Retinal fundus photograph:
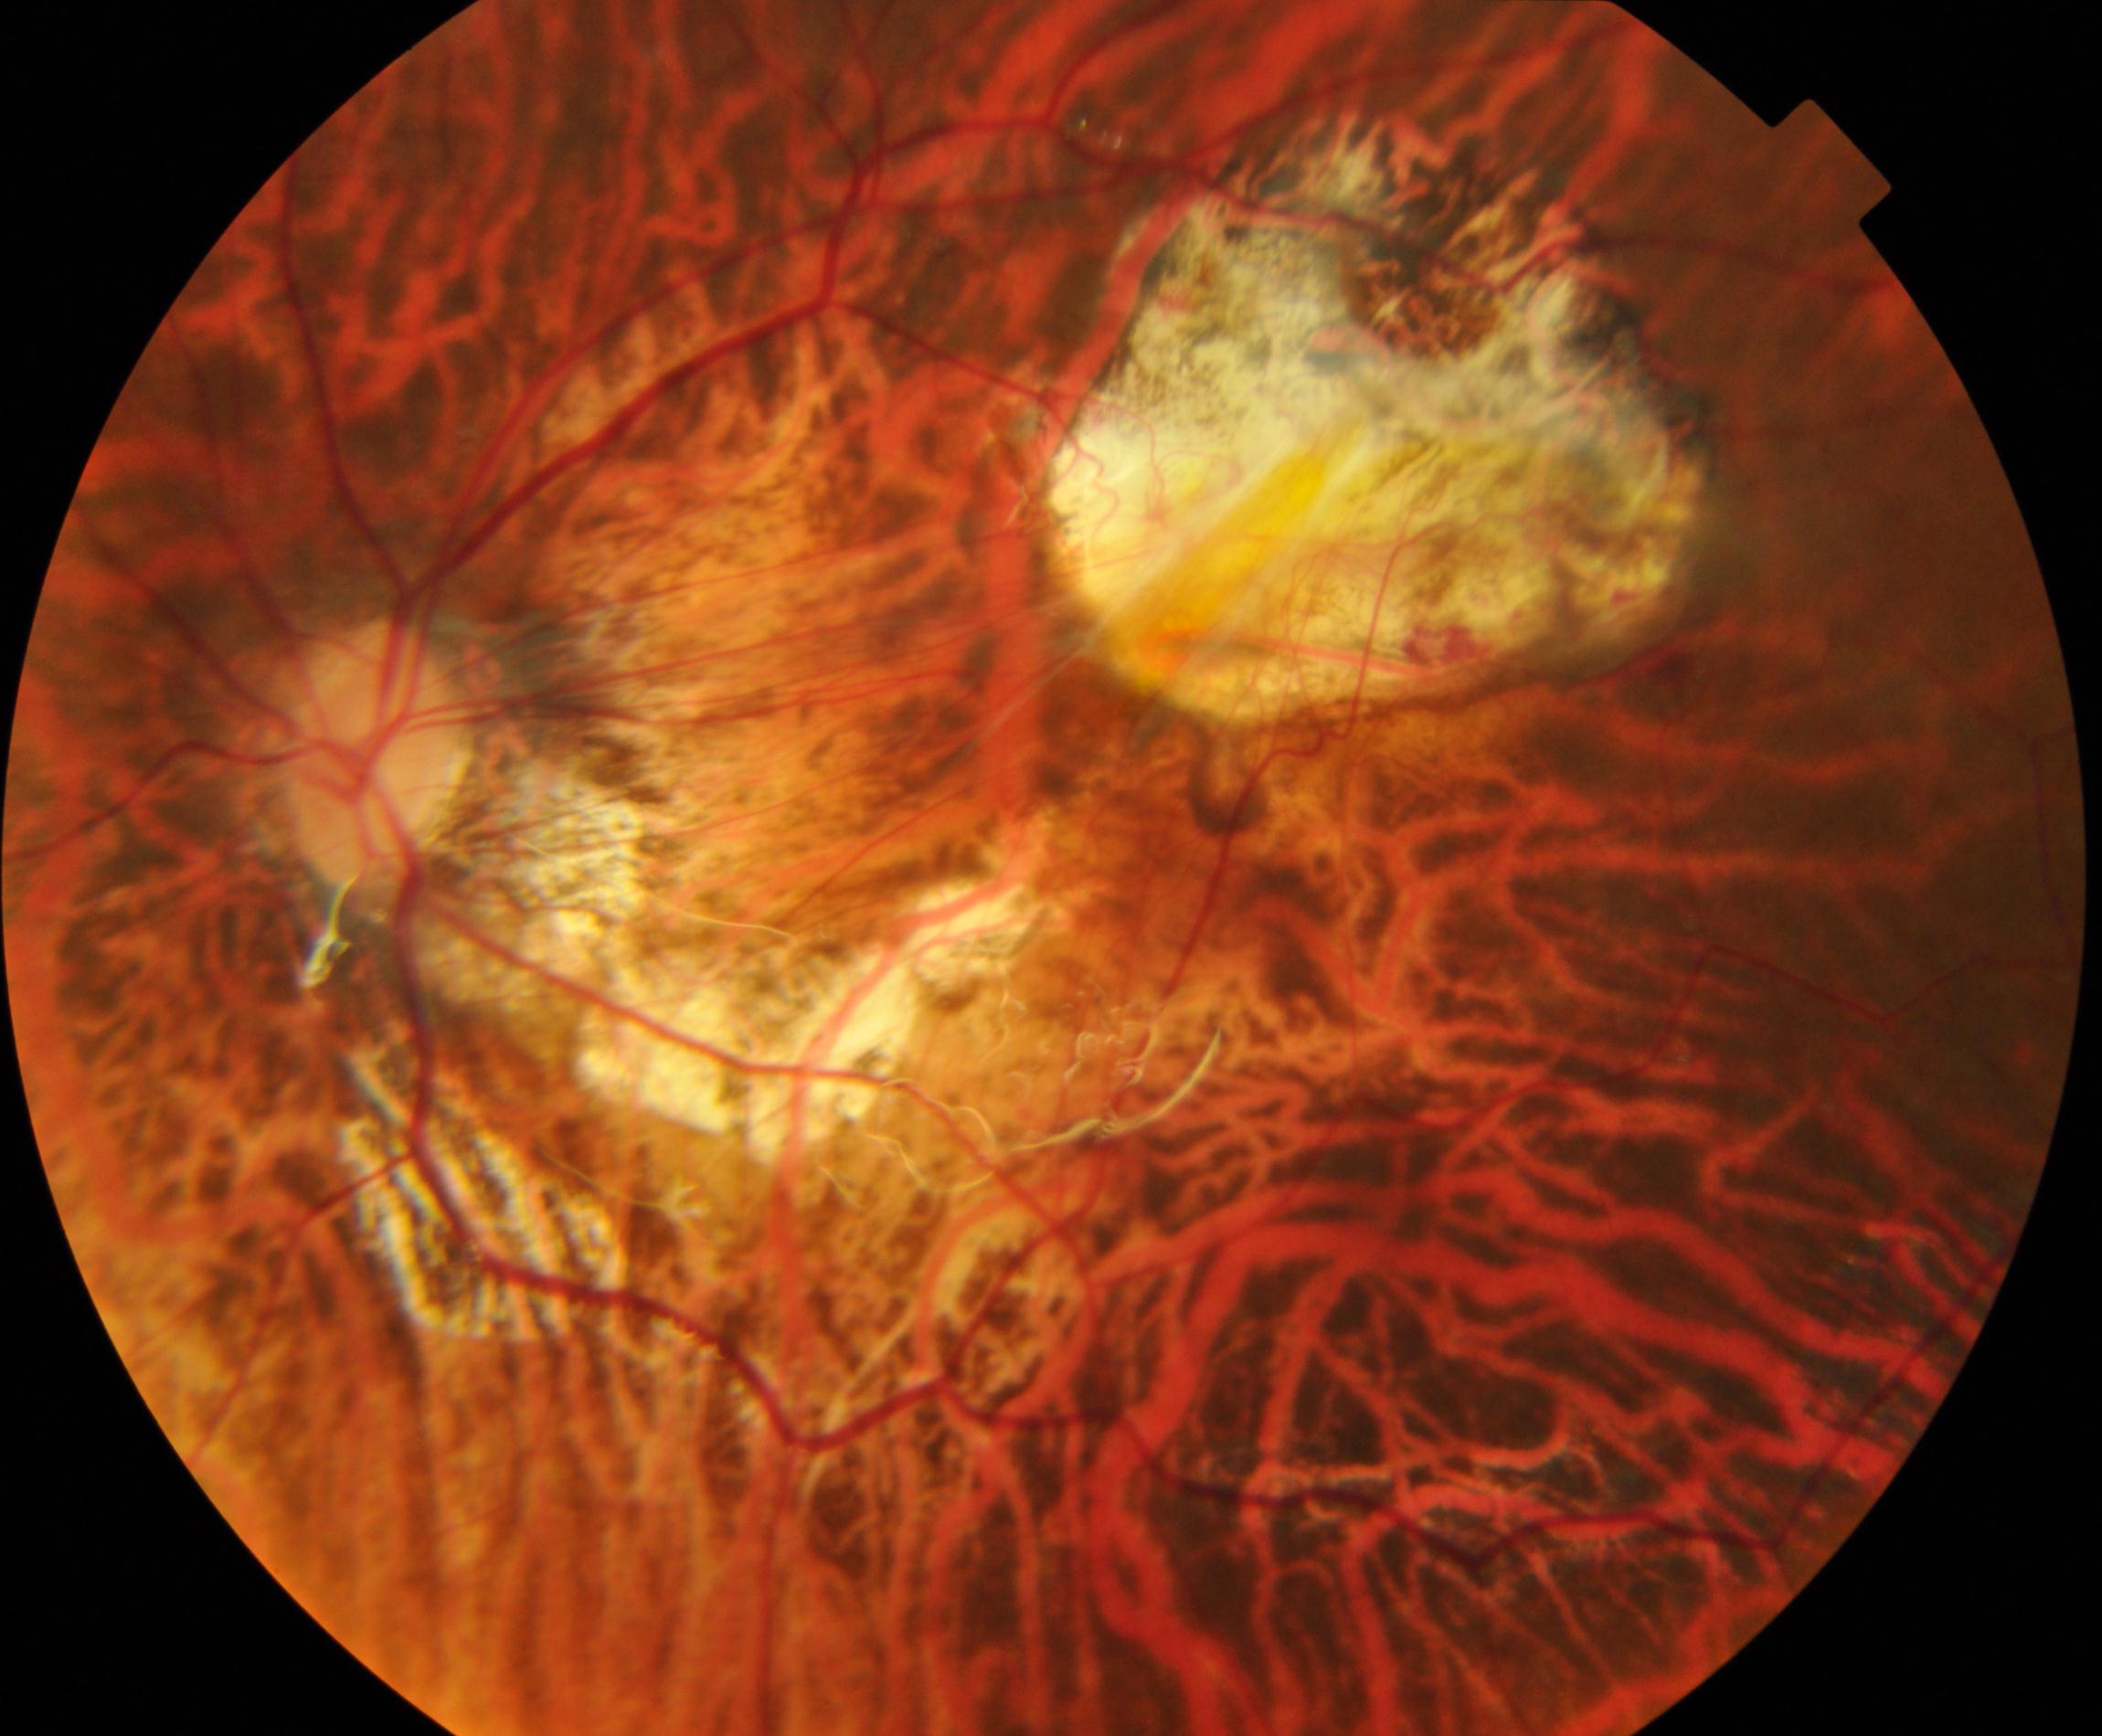

Demonstrates pathological myopia.